Captured on a Remidio smartphone fundus camera. Fundus photo:
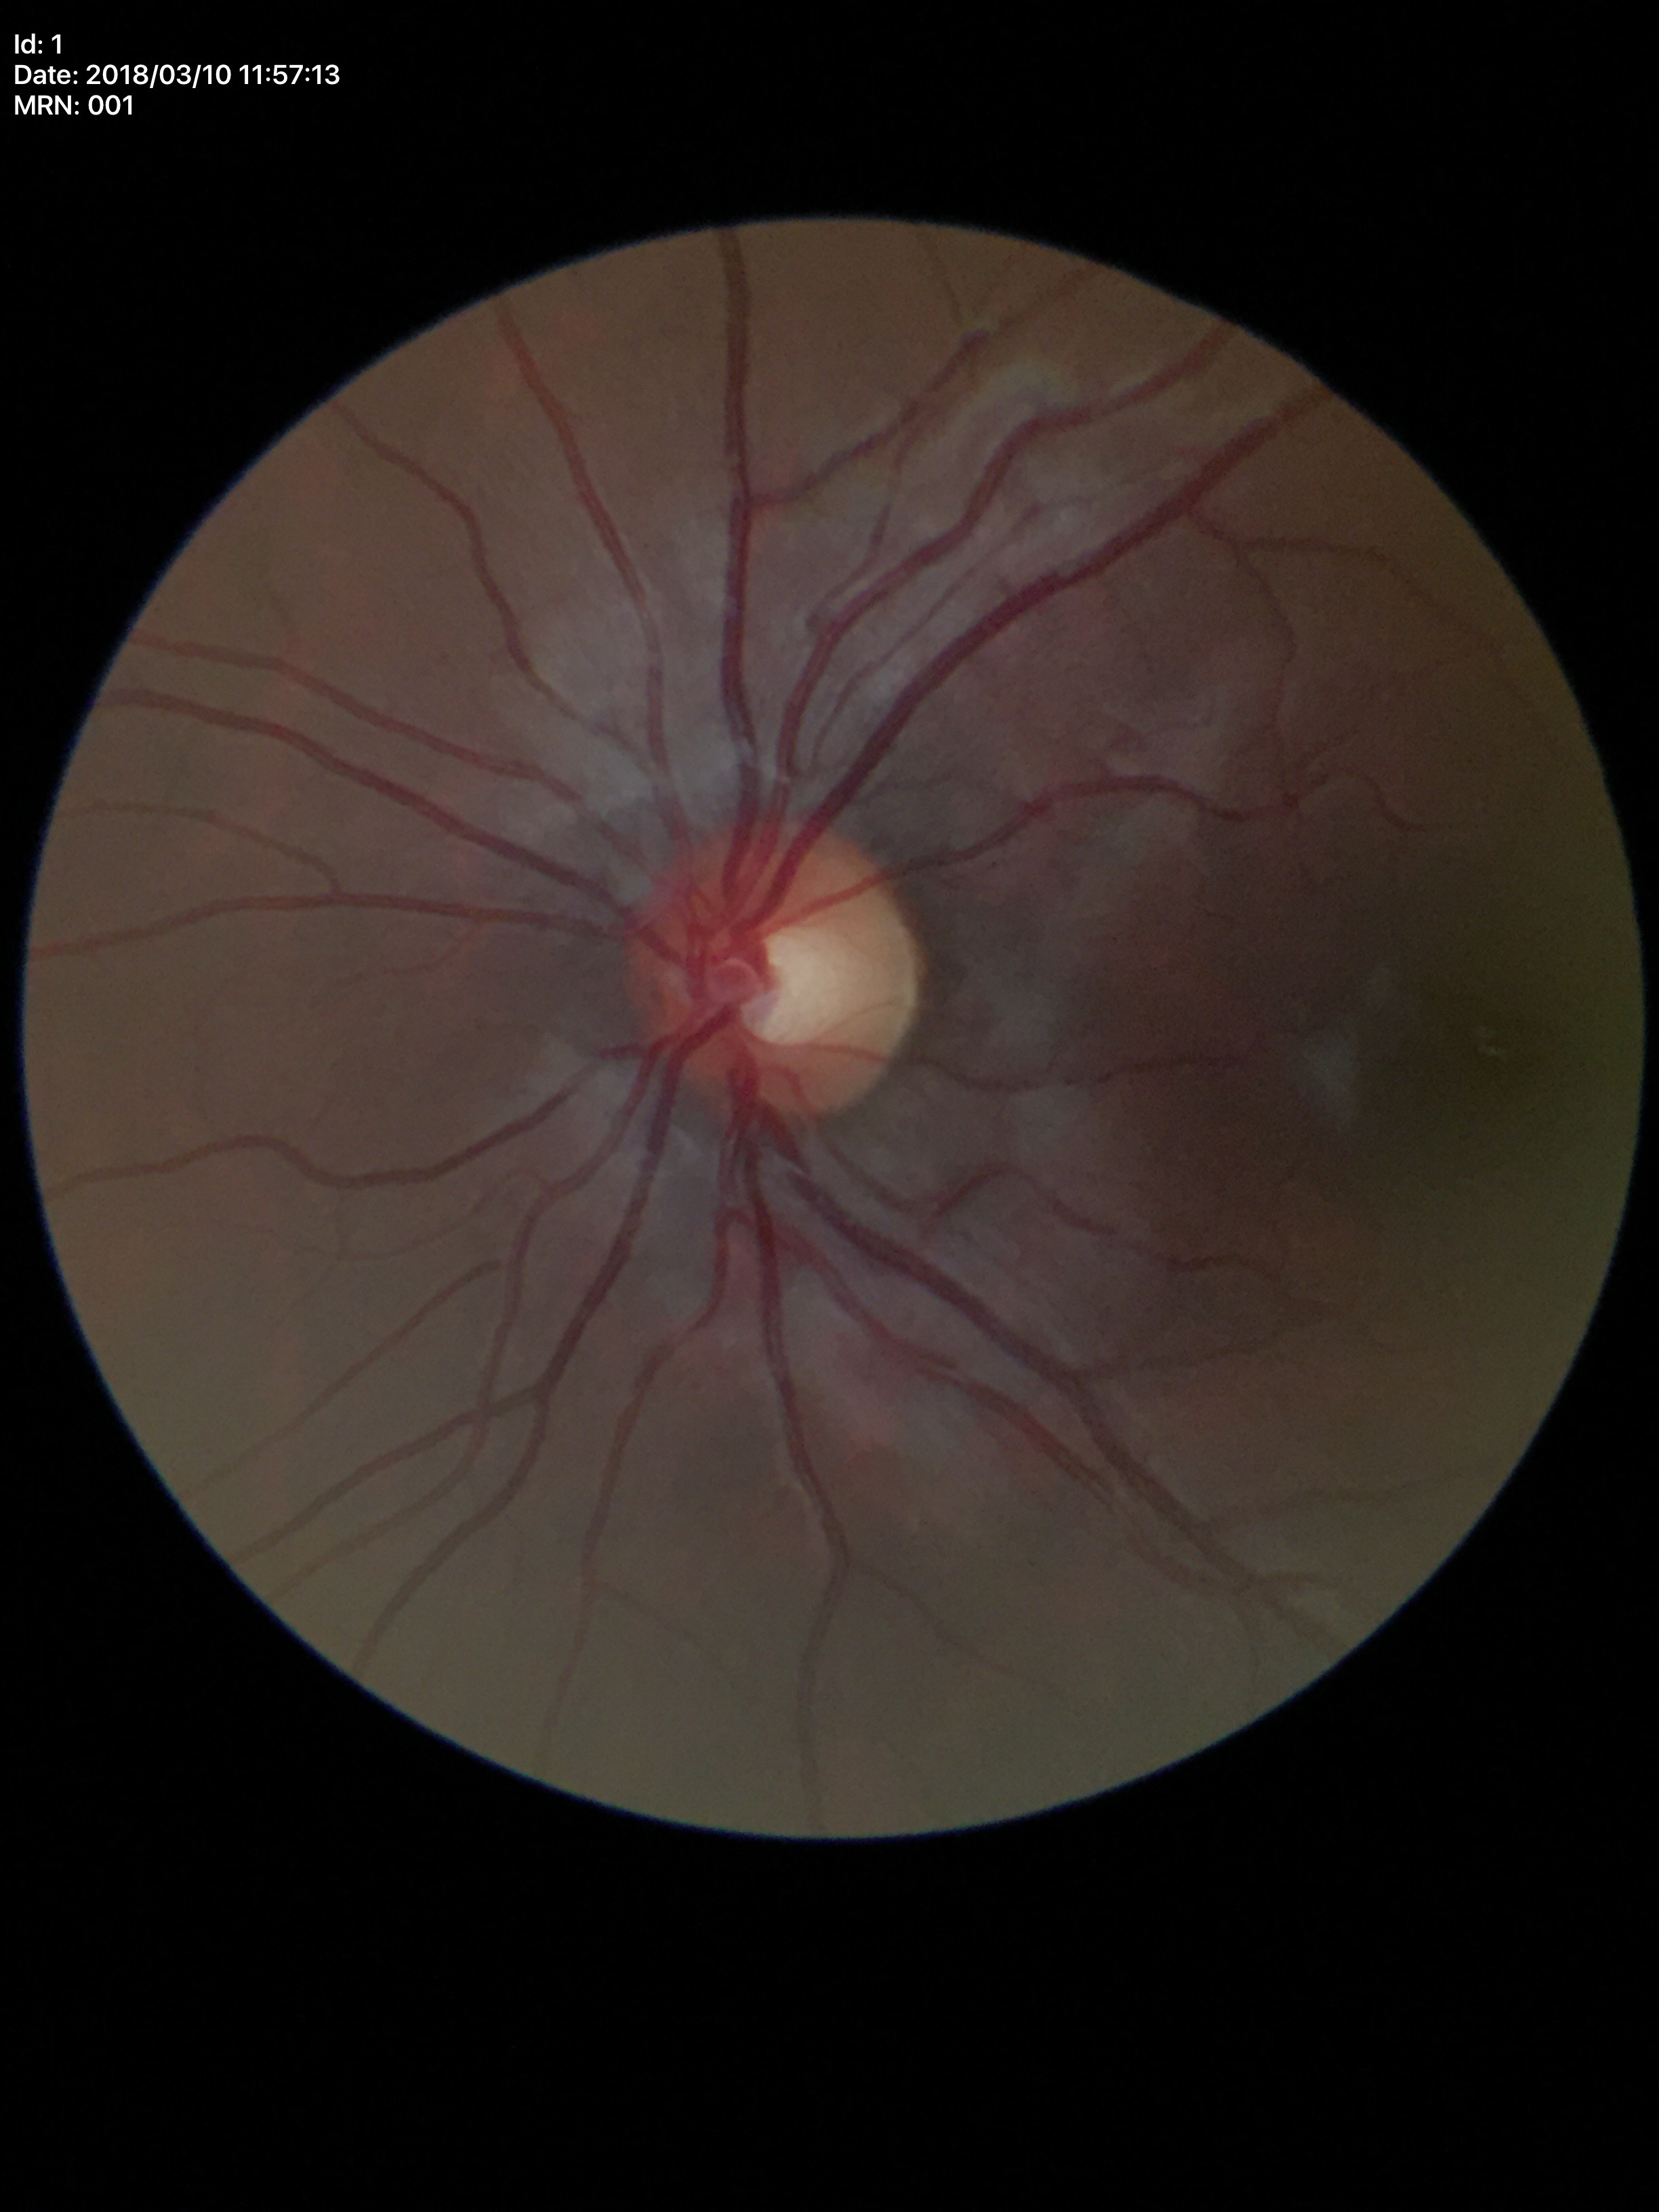 Glaucoma decision=no suspicious findings; horizontal C/D ratio=0.55; vertical cup-to-disc ratio=0.47